848 x 848 pixels; acquired with a NIDEK AFC-230
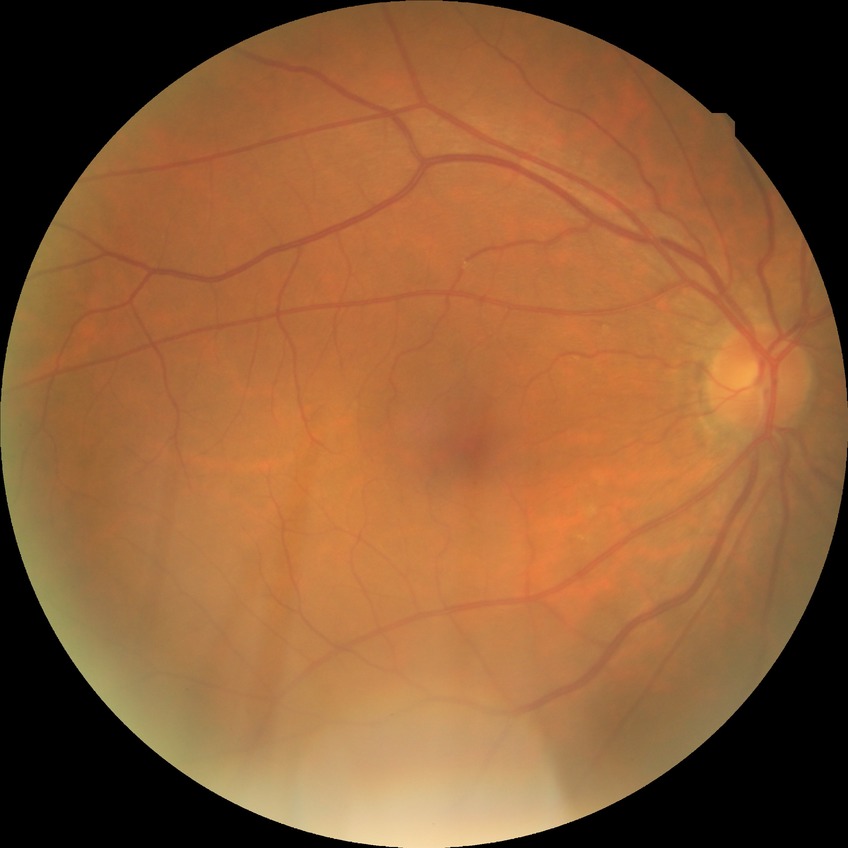 diabetic retinopathy (DR): SDR (simple diabetic retinopathy)